Phoenix ICON wide-field infant fundus image; 1240x1240; acquired on the Phoenix ICON — 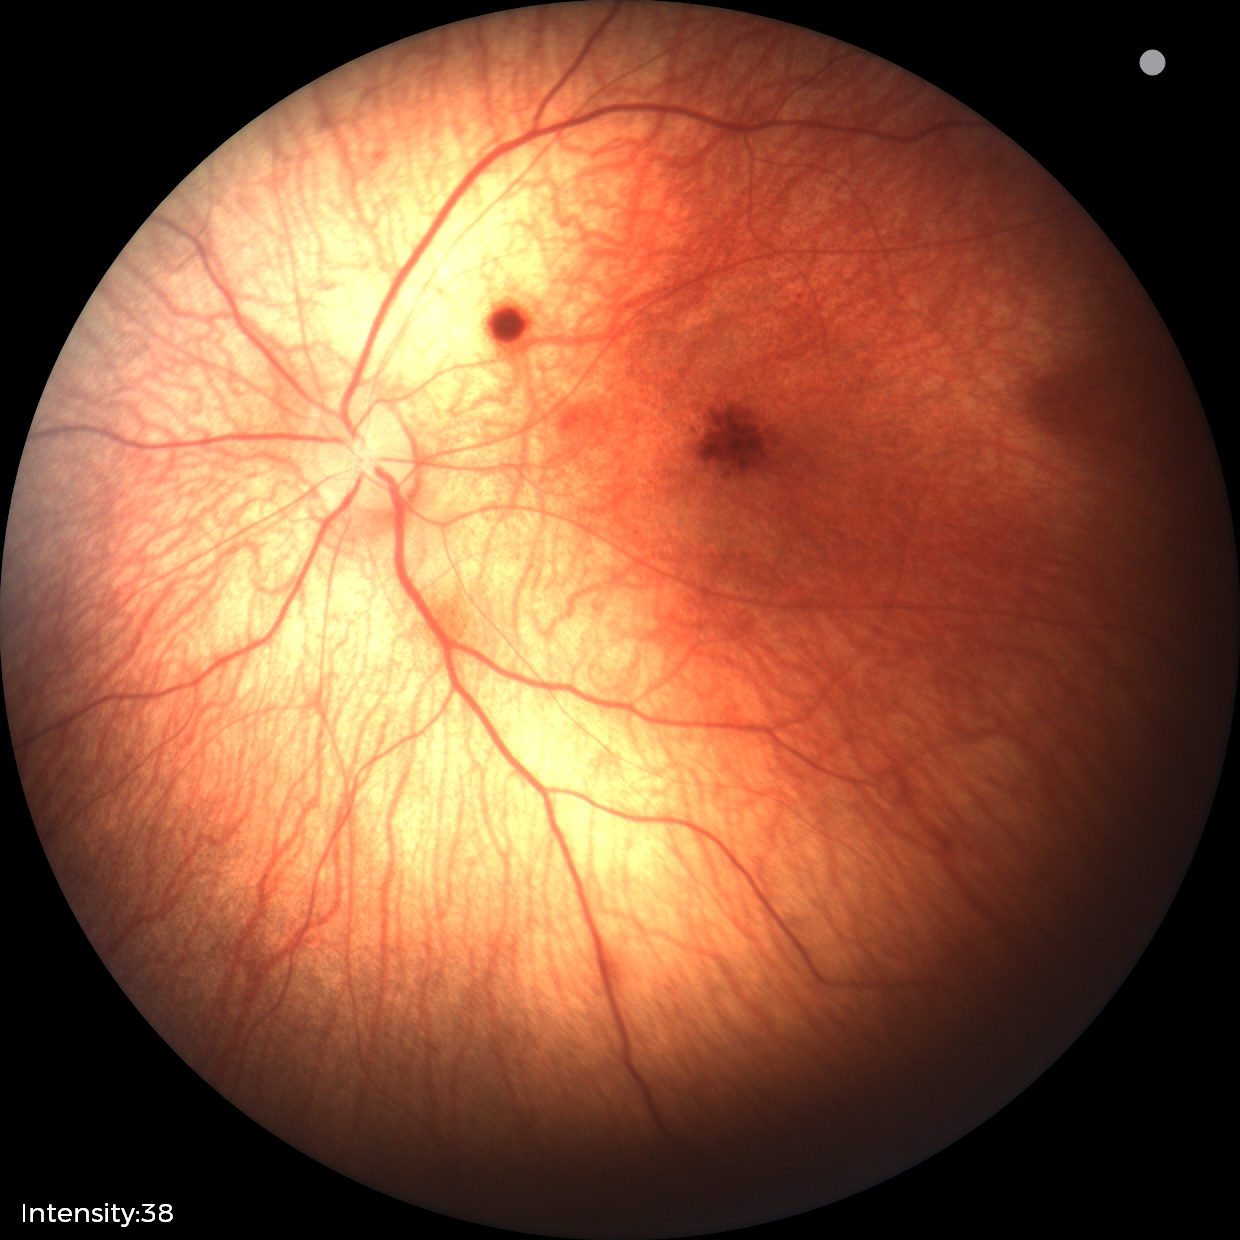

Finding = retinal hemorrhages